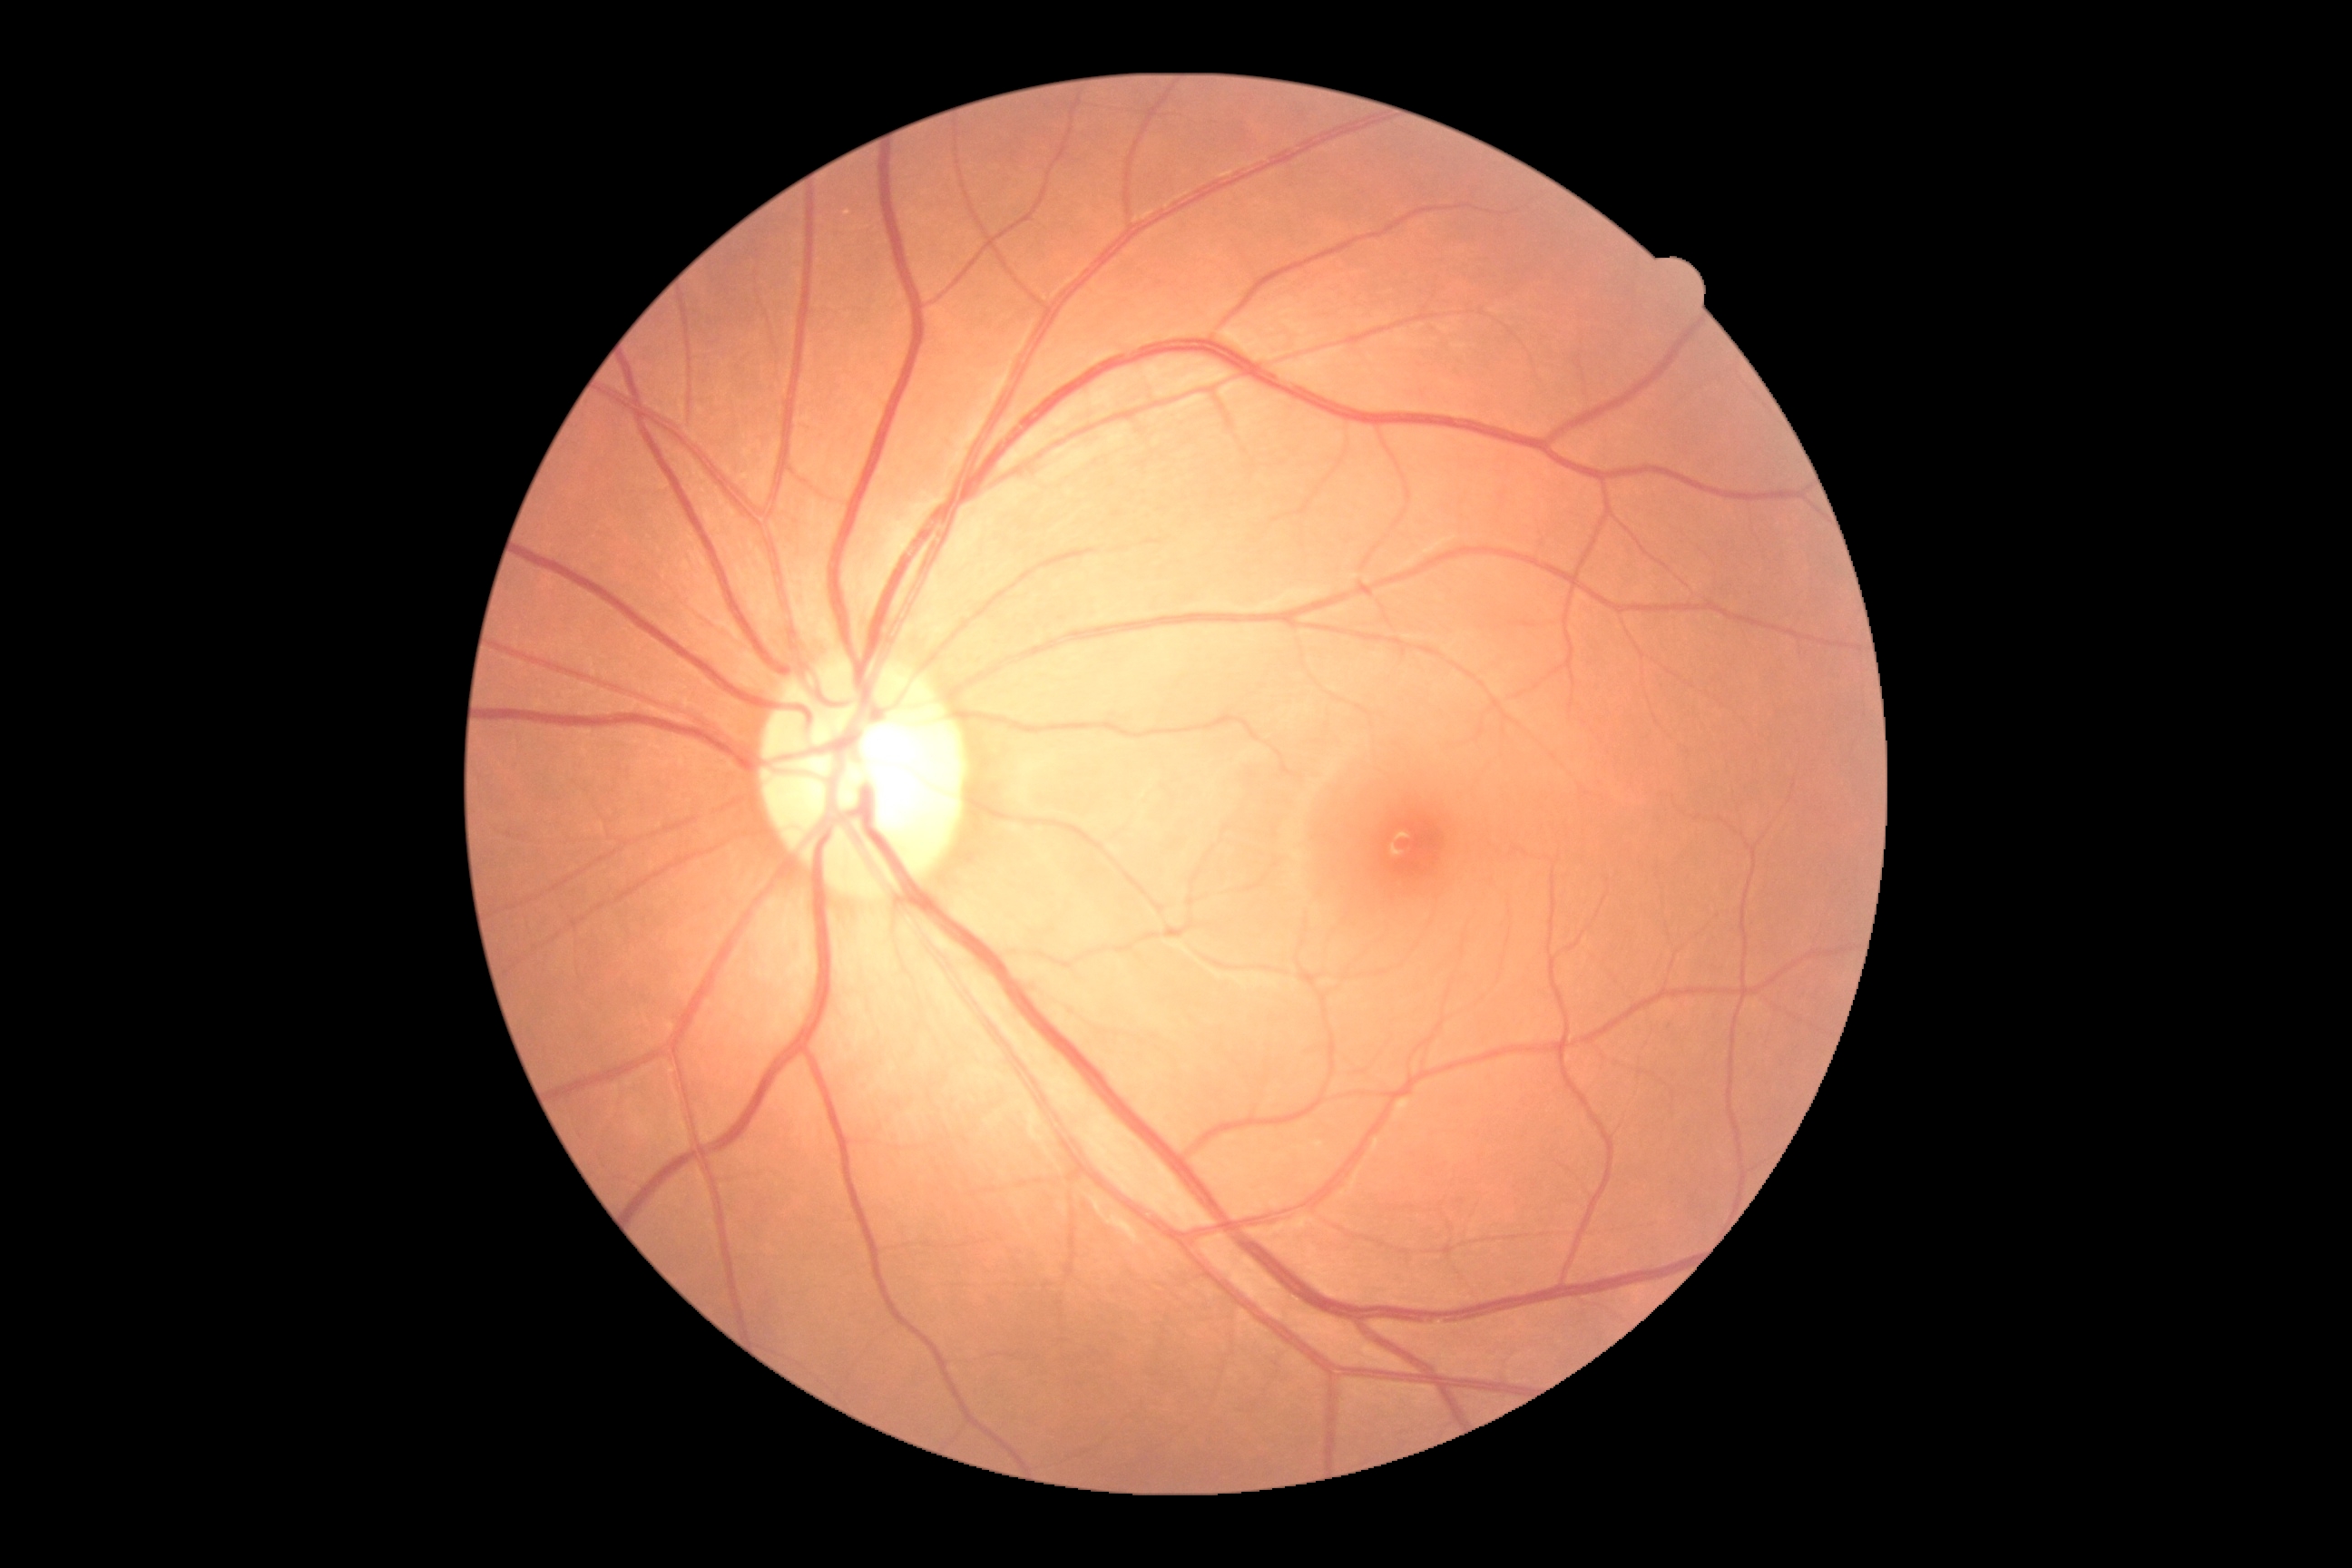

– DR — 0
– DR impression — no signs of DR